848x848
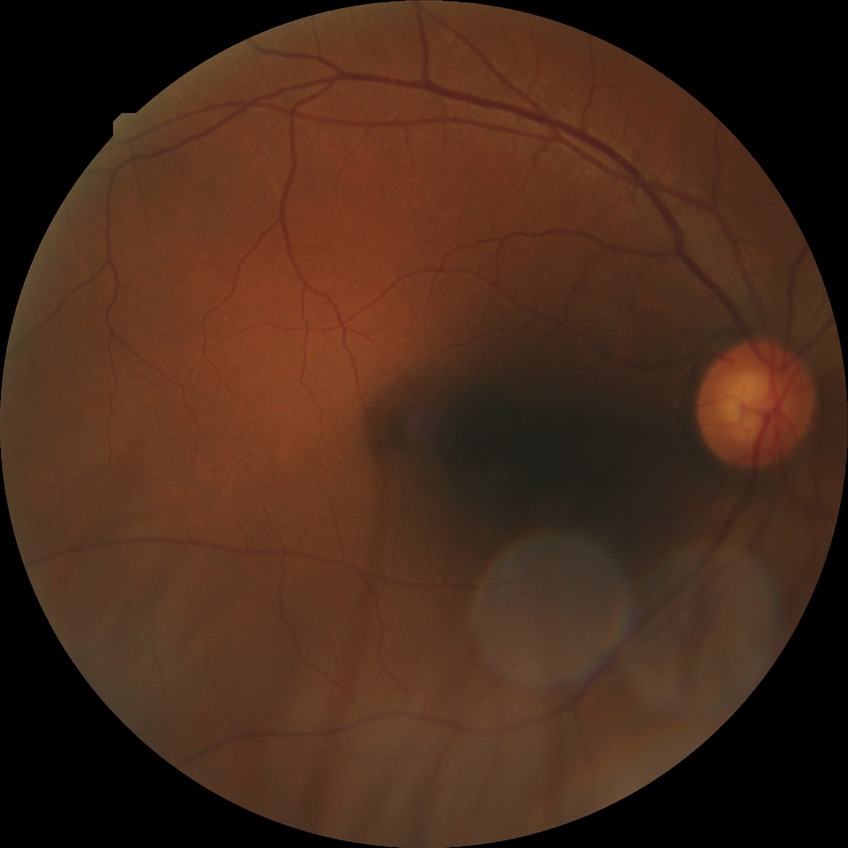
Davis grade is NDR. No DR findings.